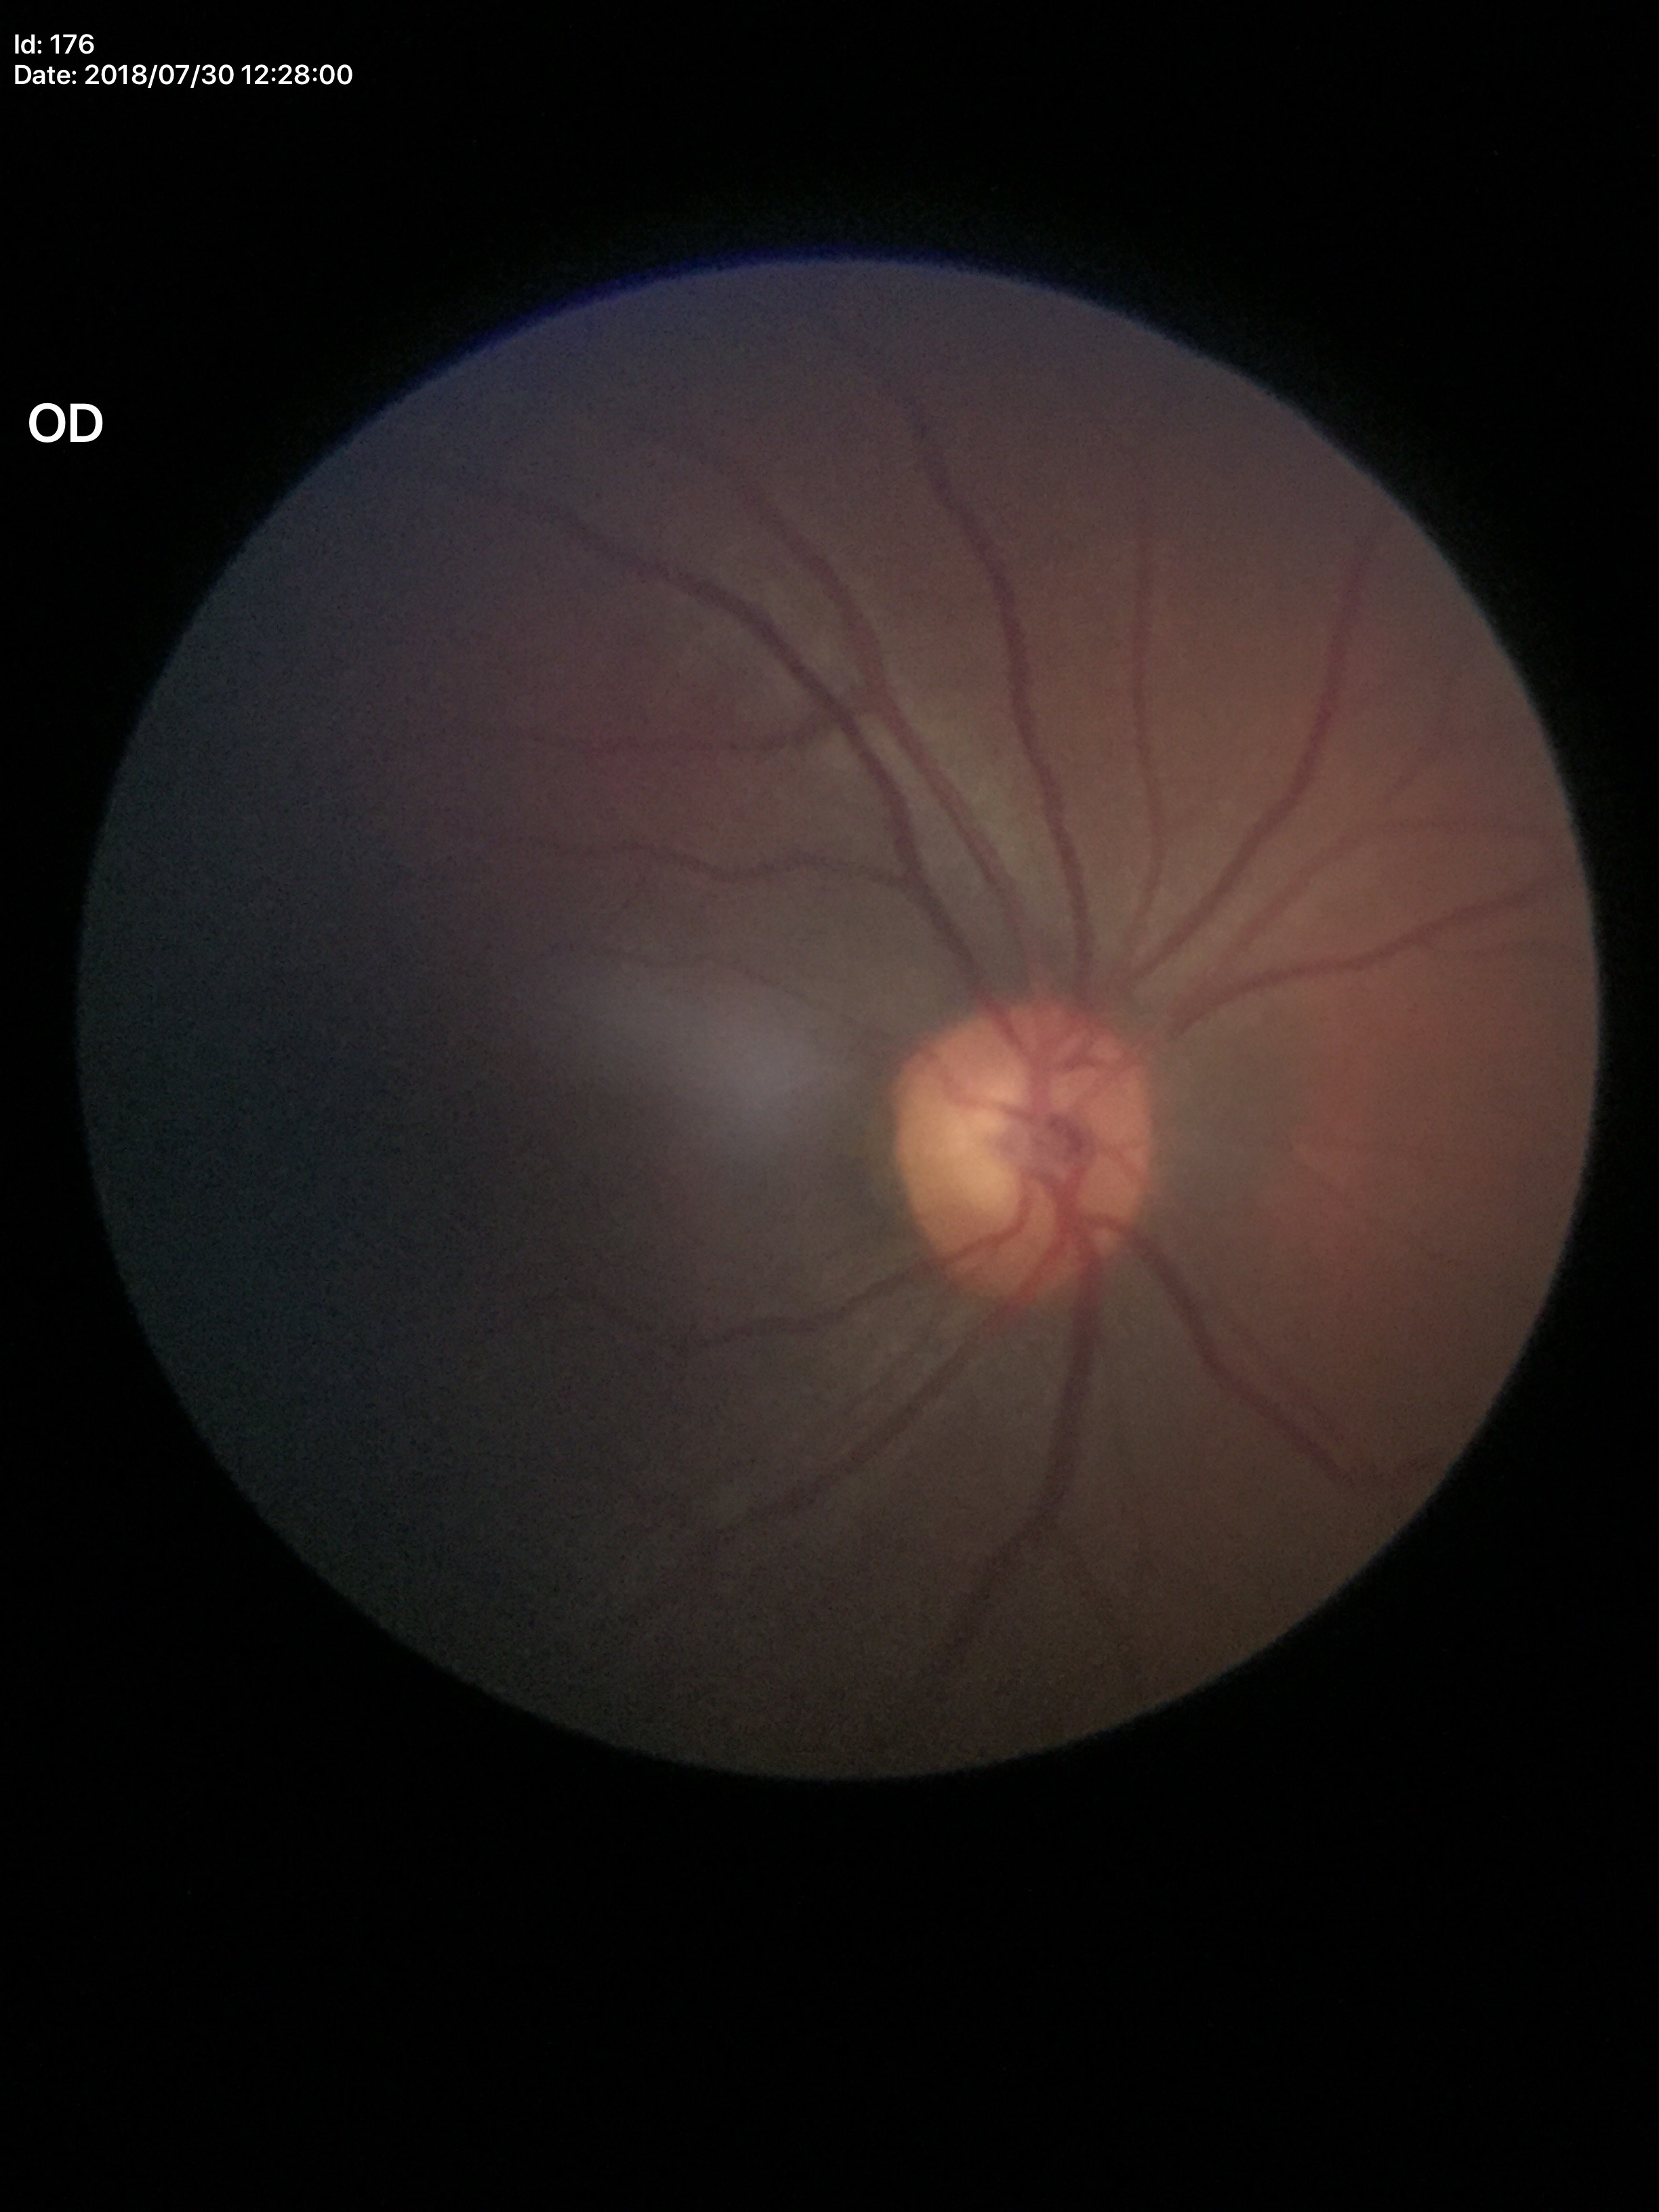 Glaucoma impression: negative.
VCDR is 0.57.